640x480. RetCam wide-field infant fundus image — 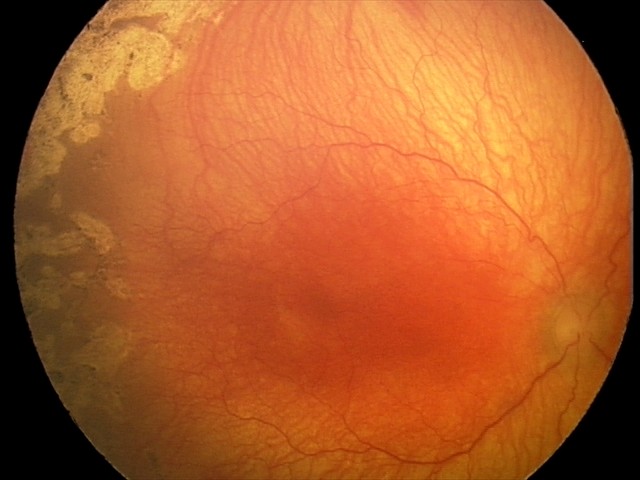

Screening diagnosis = aggressive retinopathy of prematurity (A-ROP)